Pediatric wide-field fundus photograph:
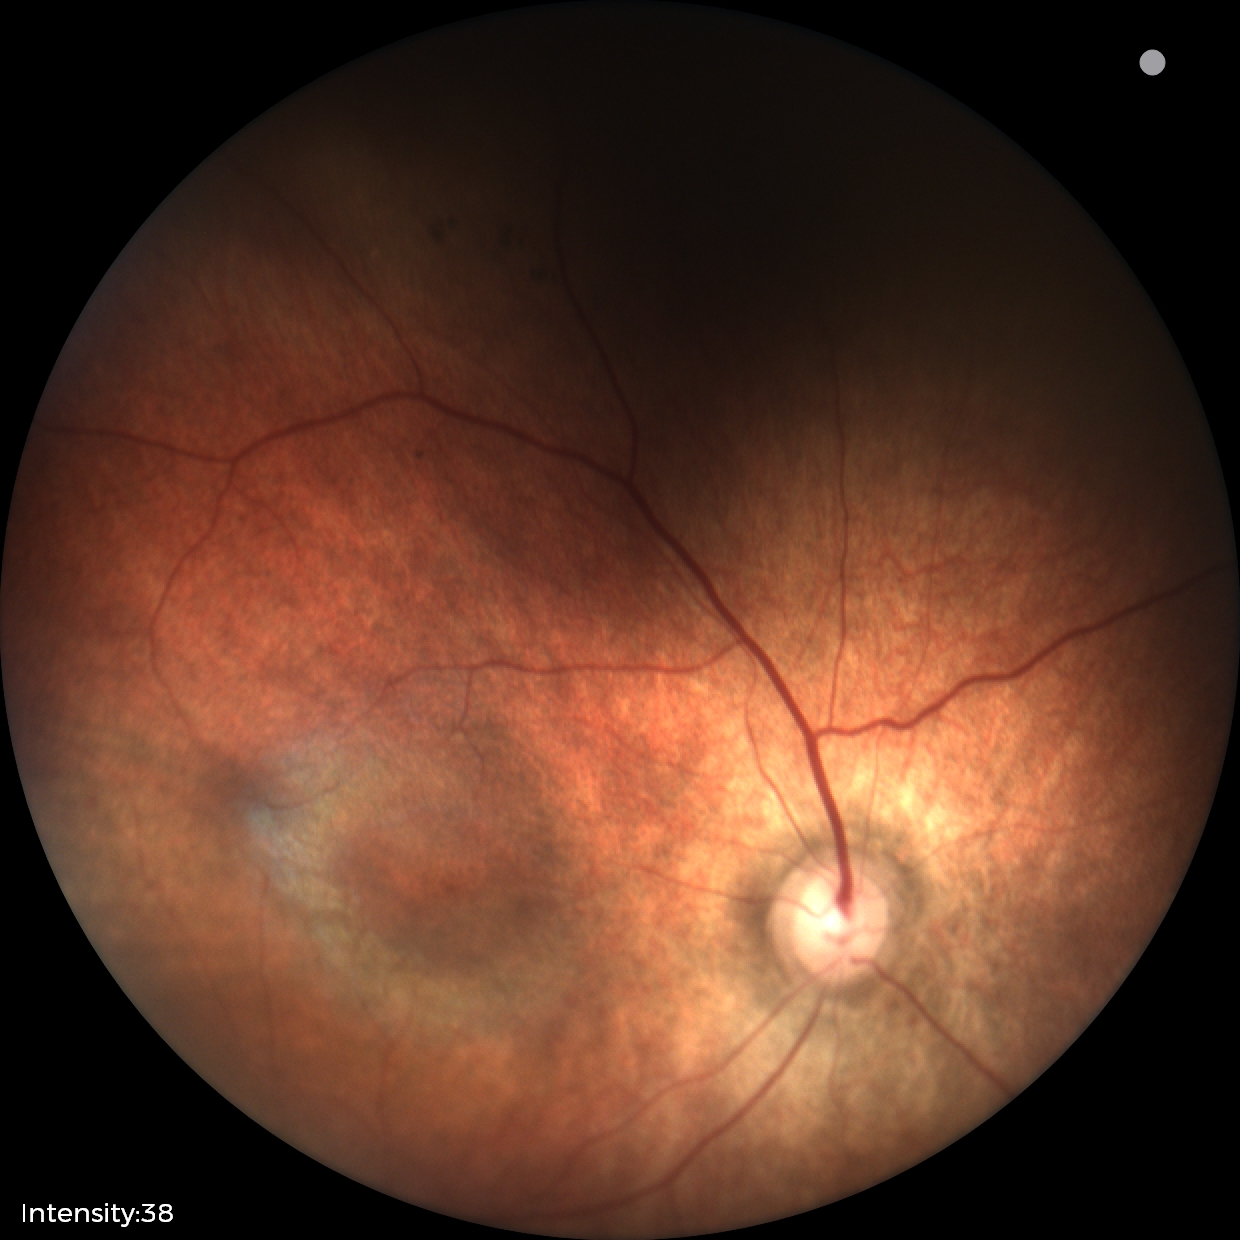
No retinal pathology identified on screening.